Pupil-dilated; image size 2228x1652 — 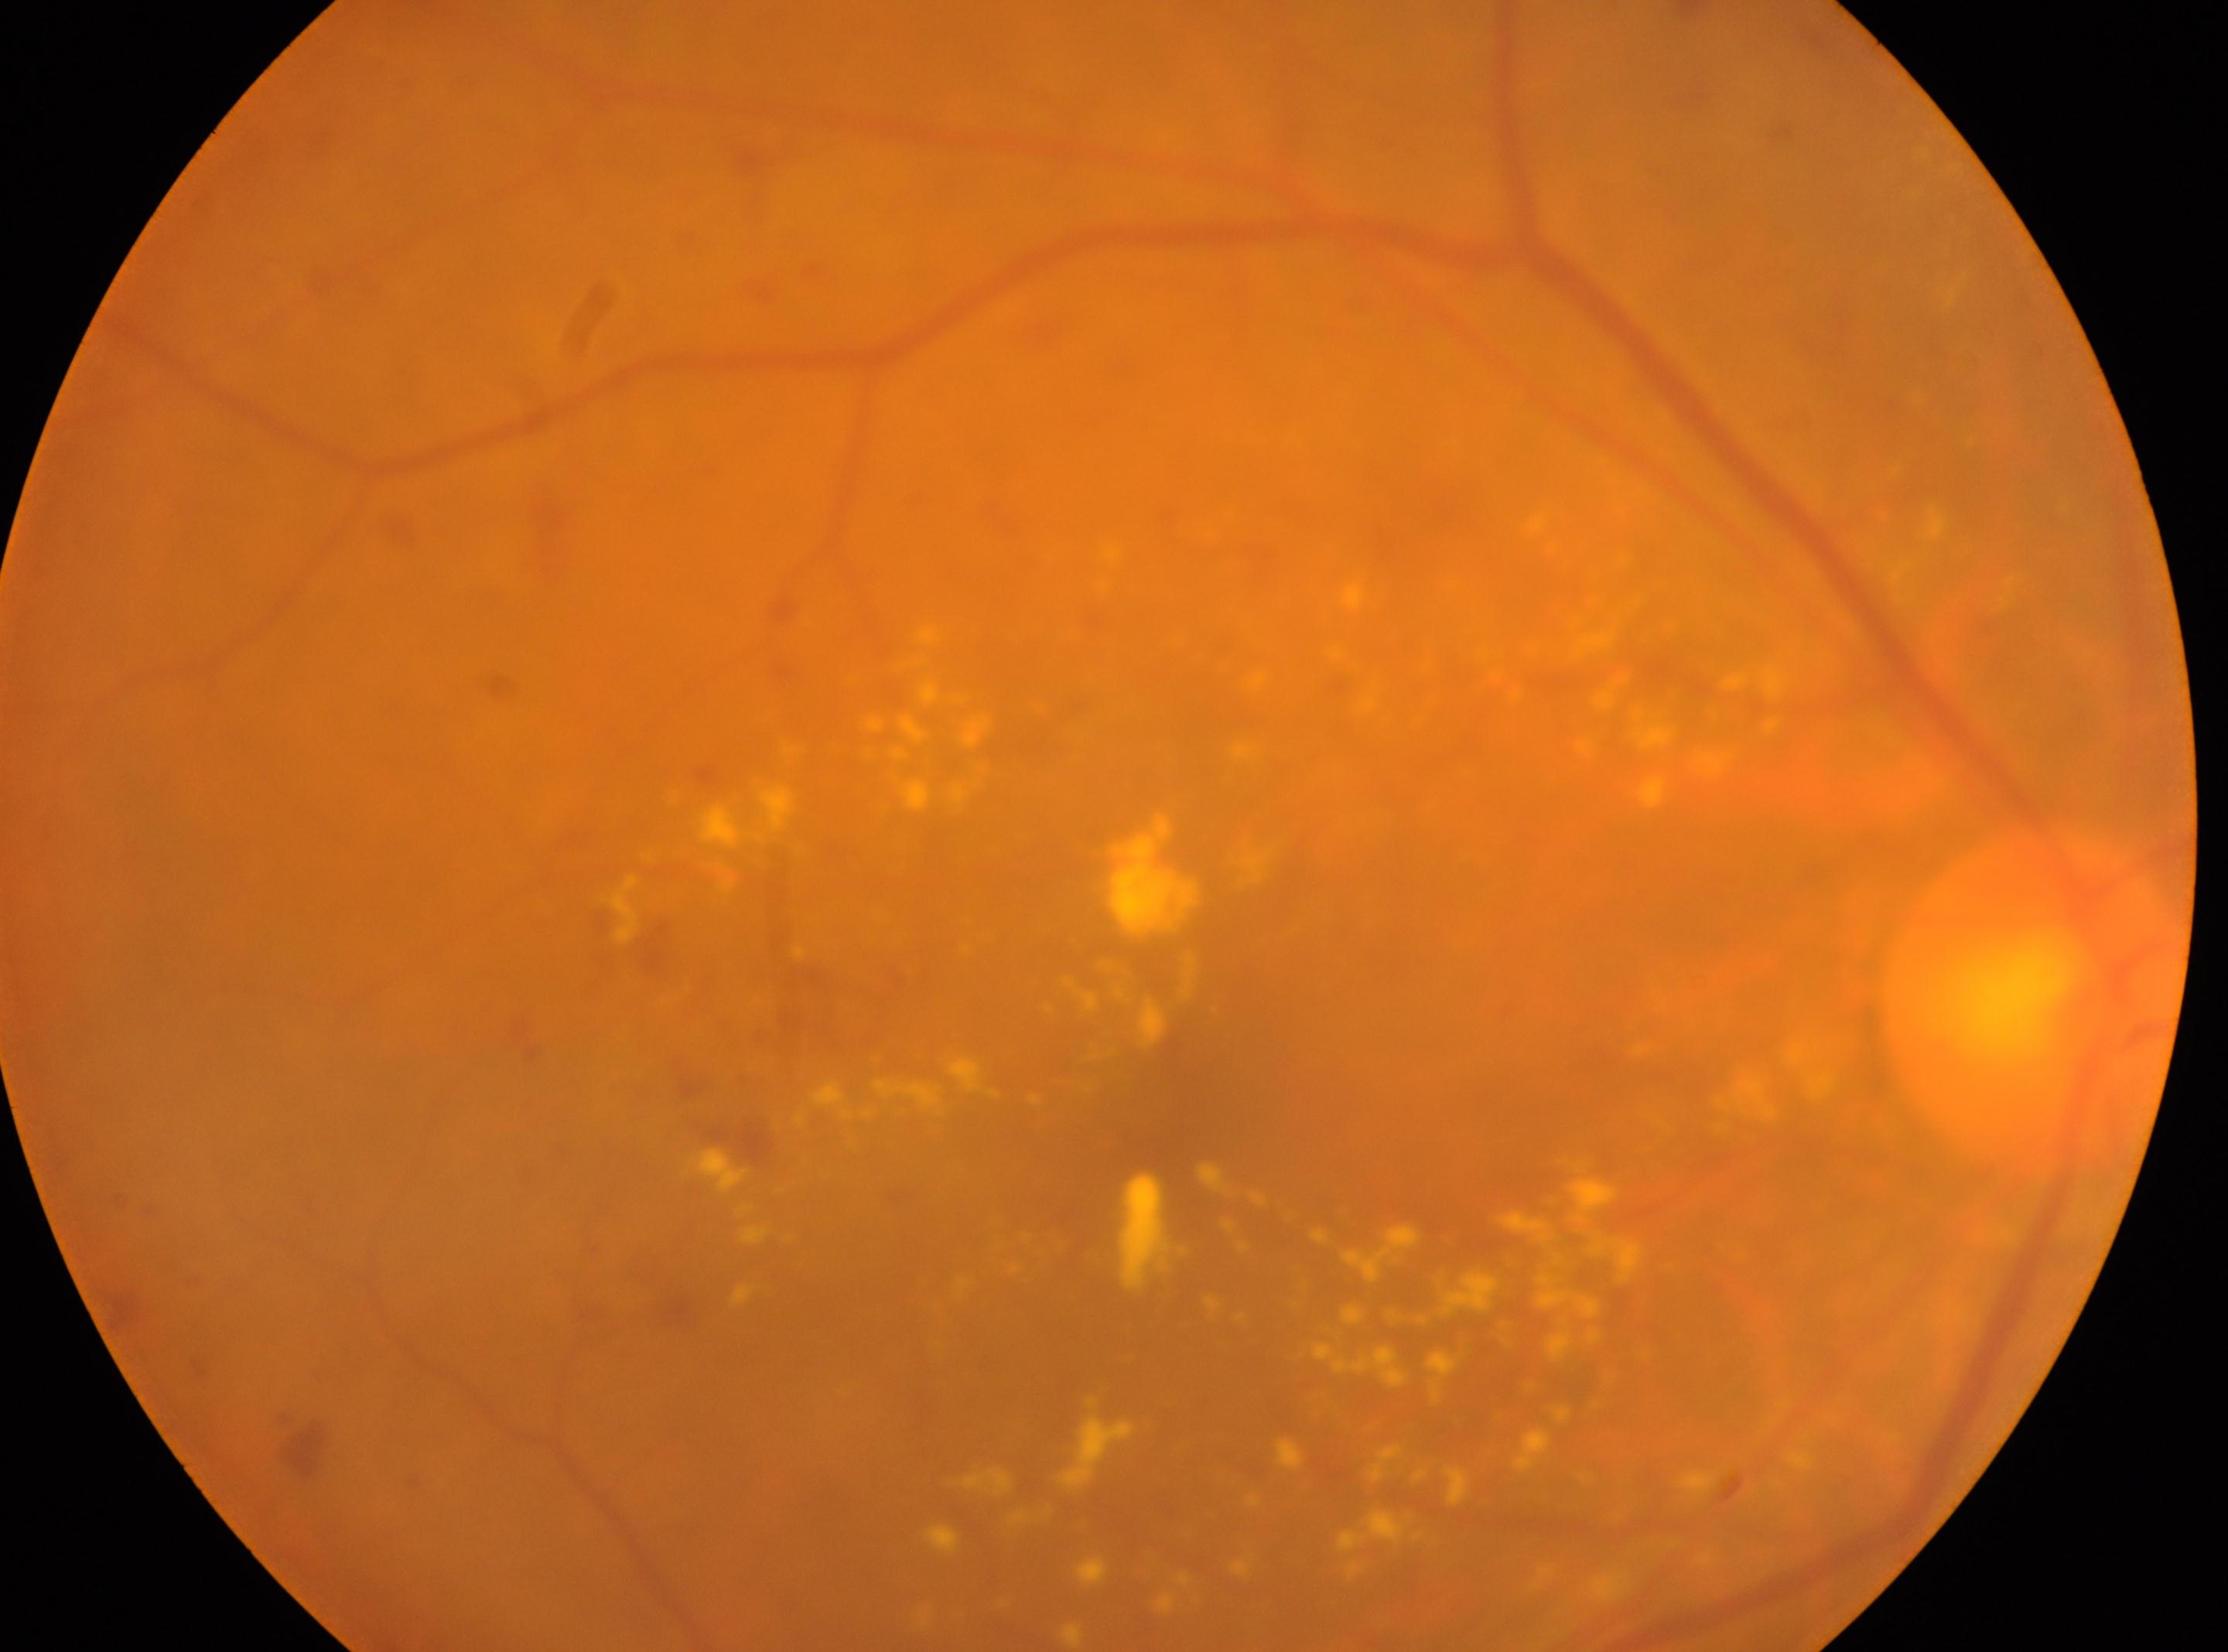

{"eye": "the right eye", "dr_grade": "2 (moderate NPDR)", "fovea": "1162px, 1115px", "optic_disc": "2032px, 996px"}